Retinal fundus photograph.
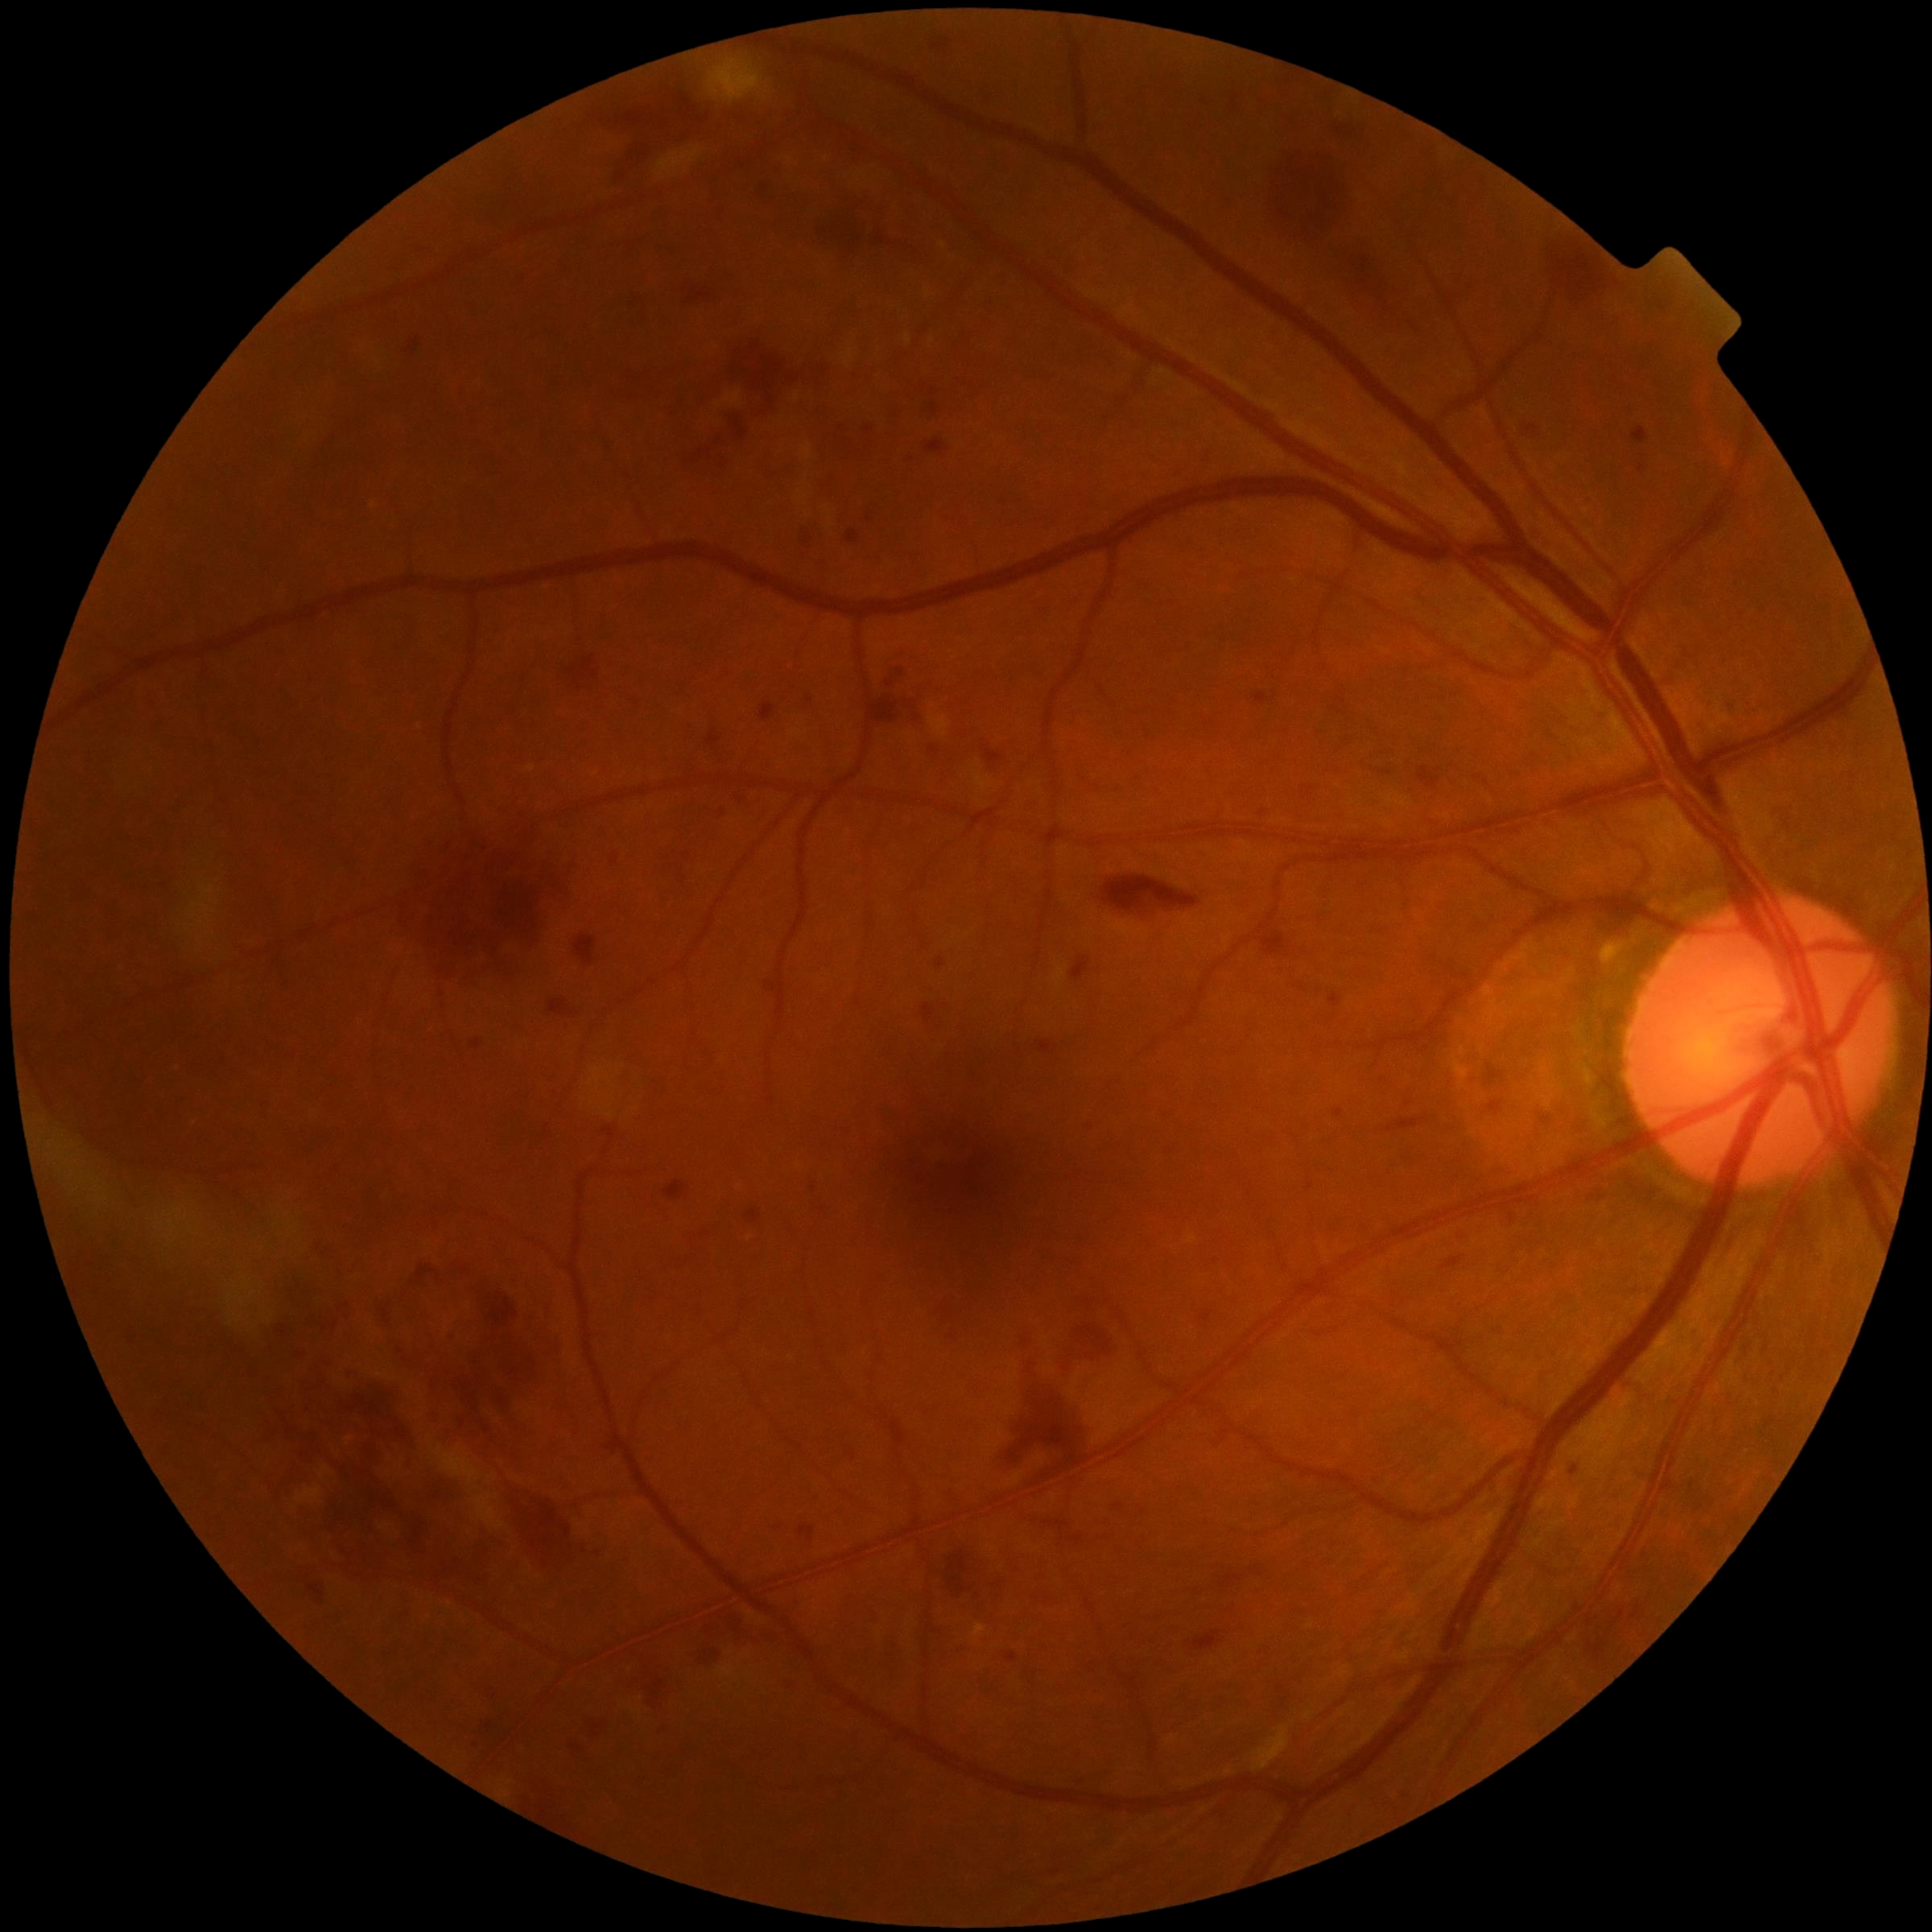

diabetic retinopathy (DR)@grade 3 — more than 20 intraretinal hemorrhages in each of 4 quadrants, definite venous beading in 2 or more quadrants, or prominent intraretinal microvascular abnormalities in 1 or more quadrants, with no signs of proliferative retinopathy.